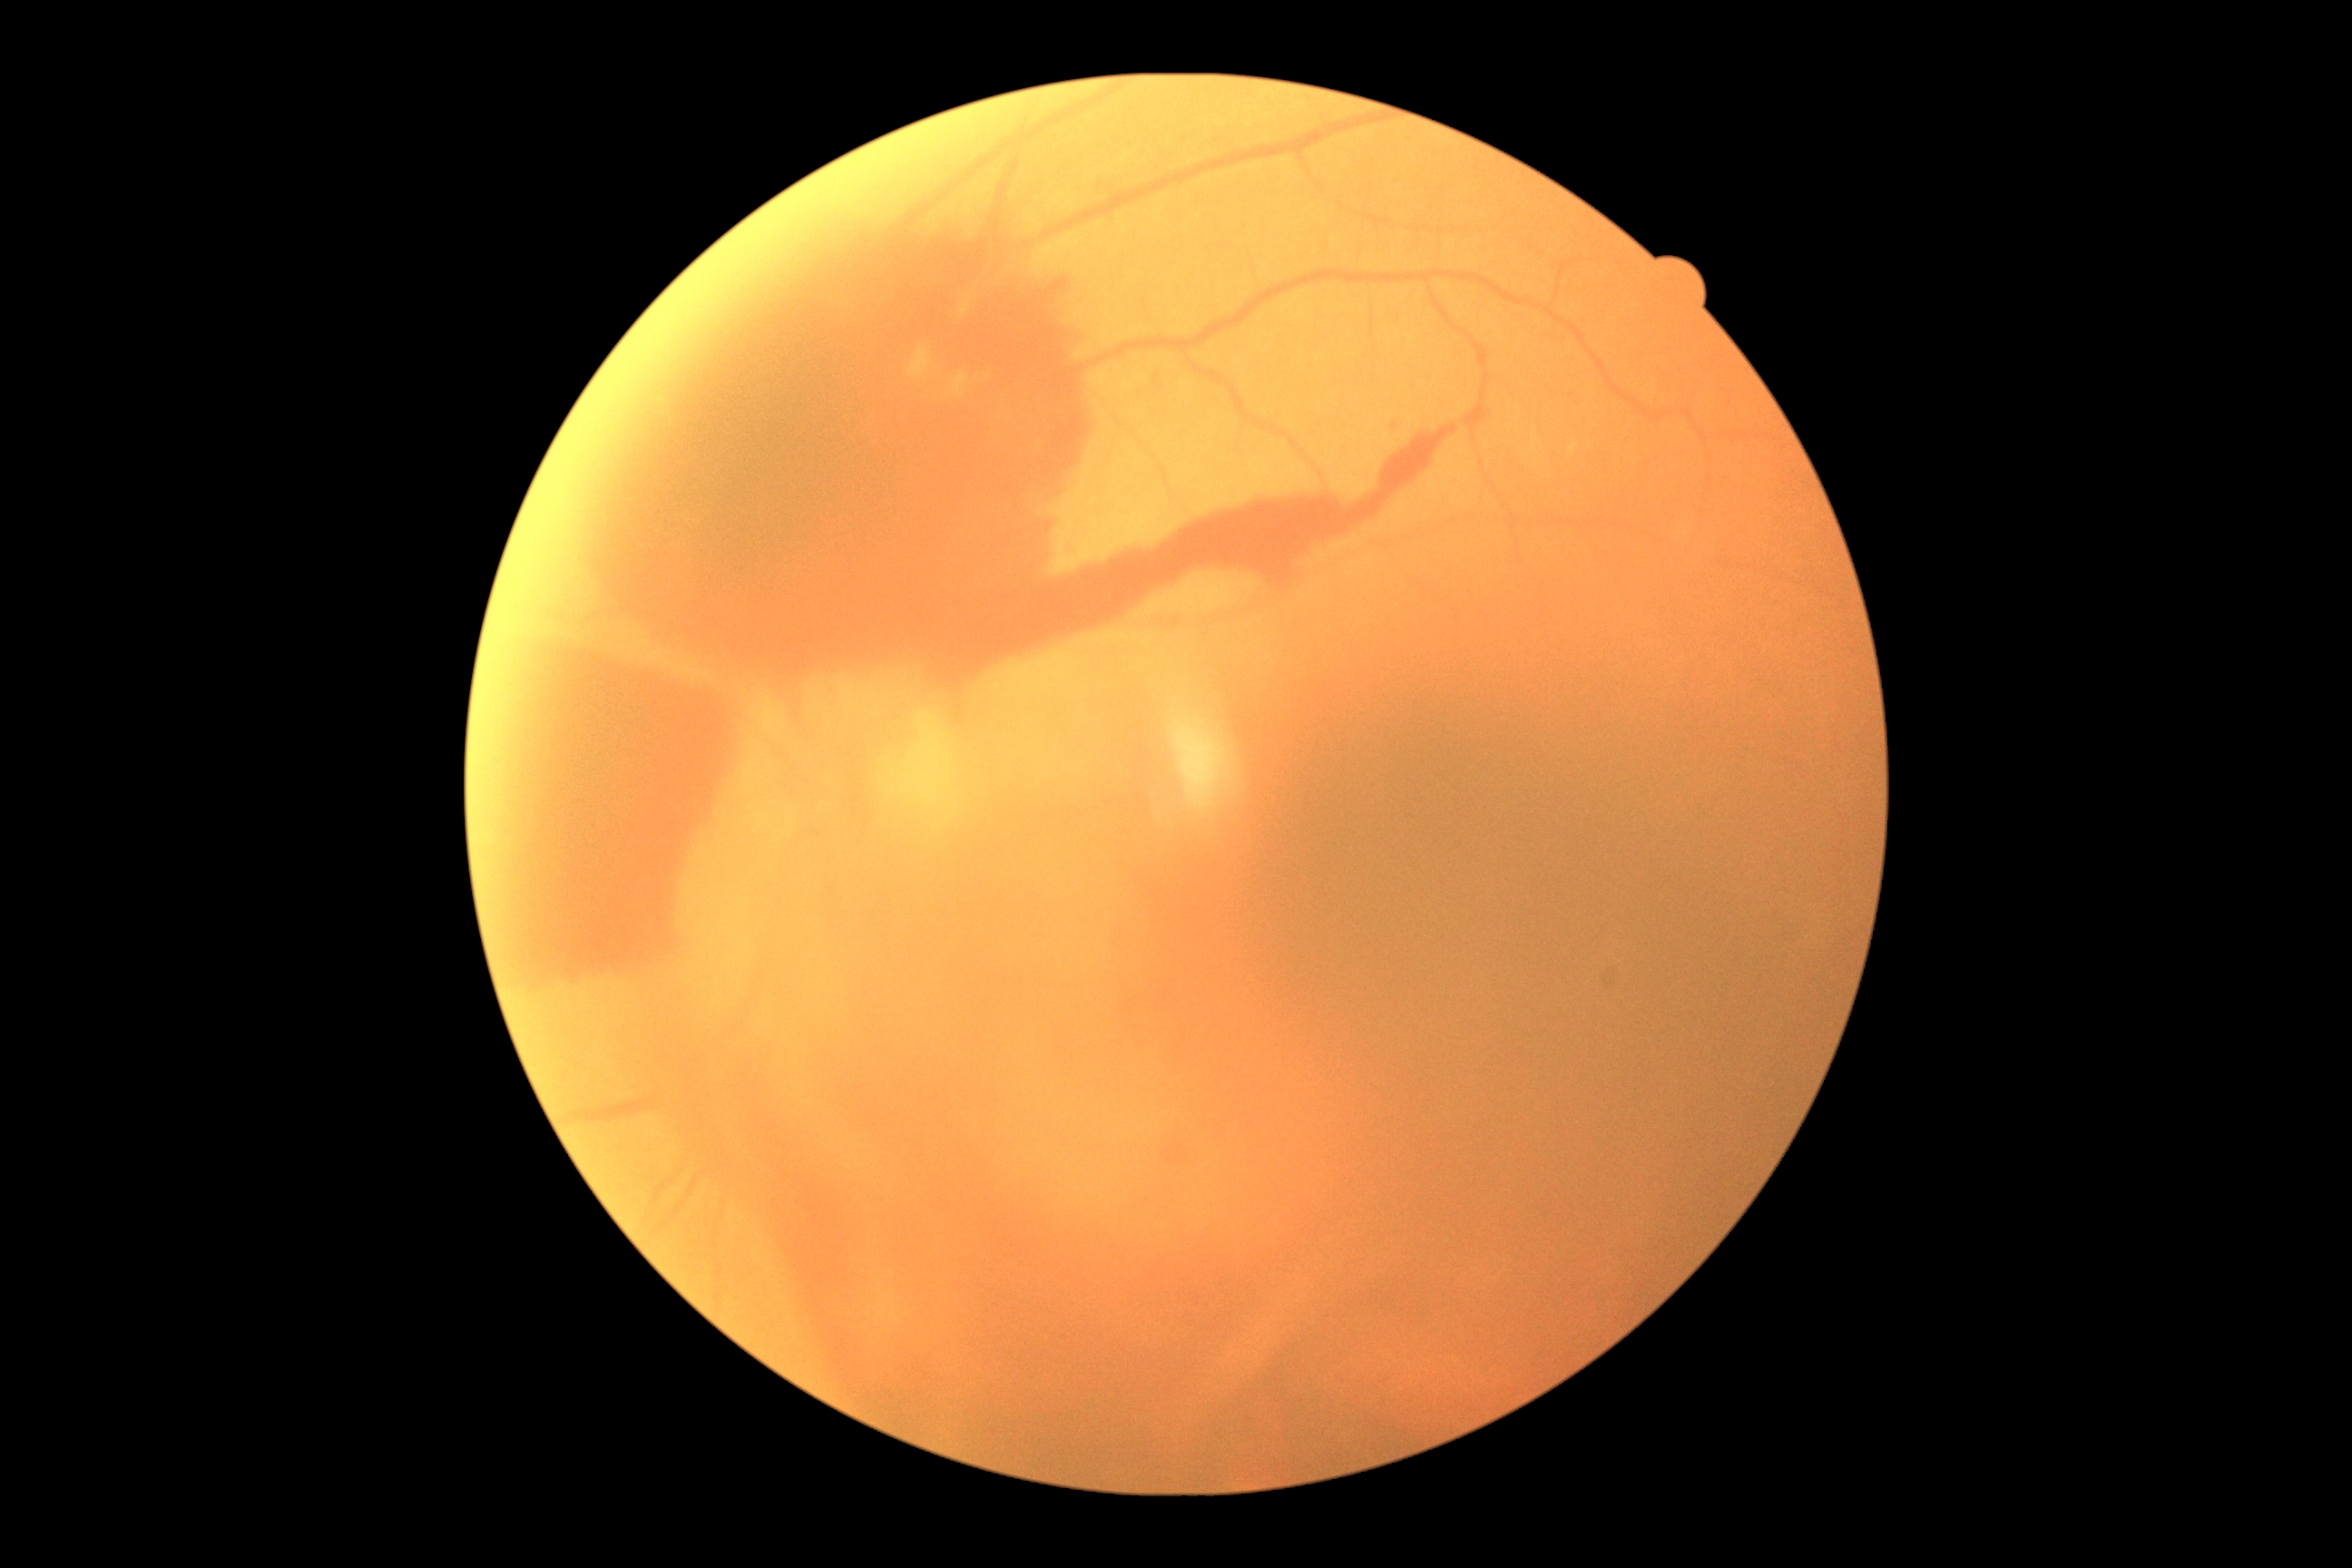 Findings:
– DR grade: 4/4
– DR class: proliferative diabetic retinopathy